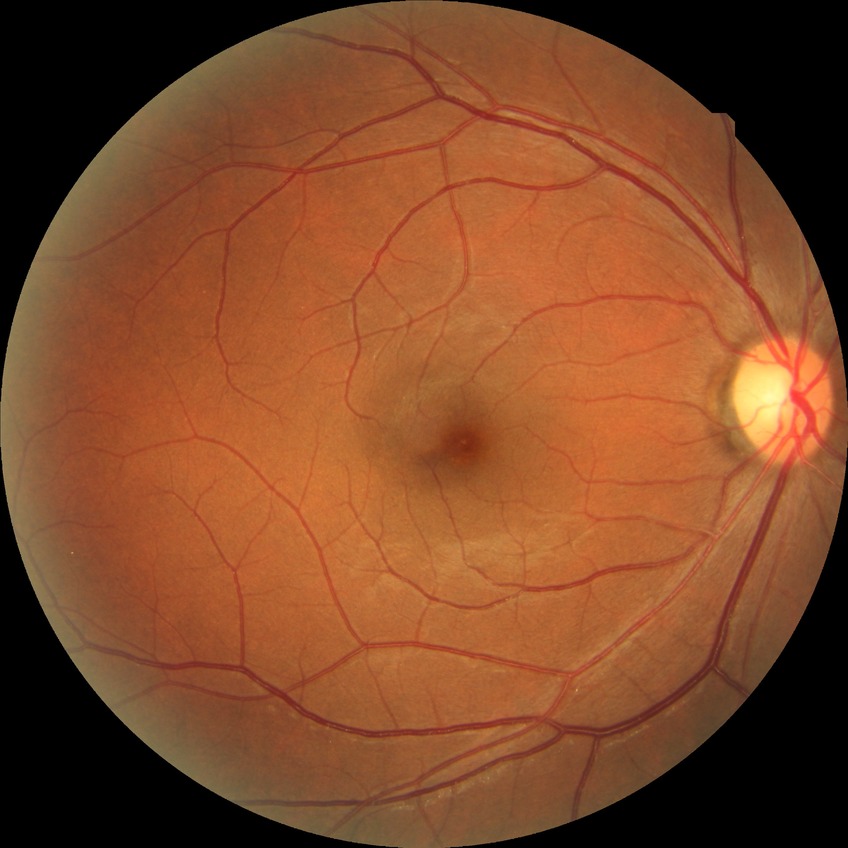 Diabetic retinopathy stage is no diabetic retinopathy.